RetCam wide-field infant fundus image: 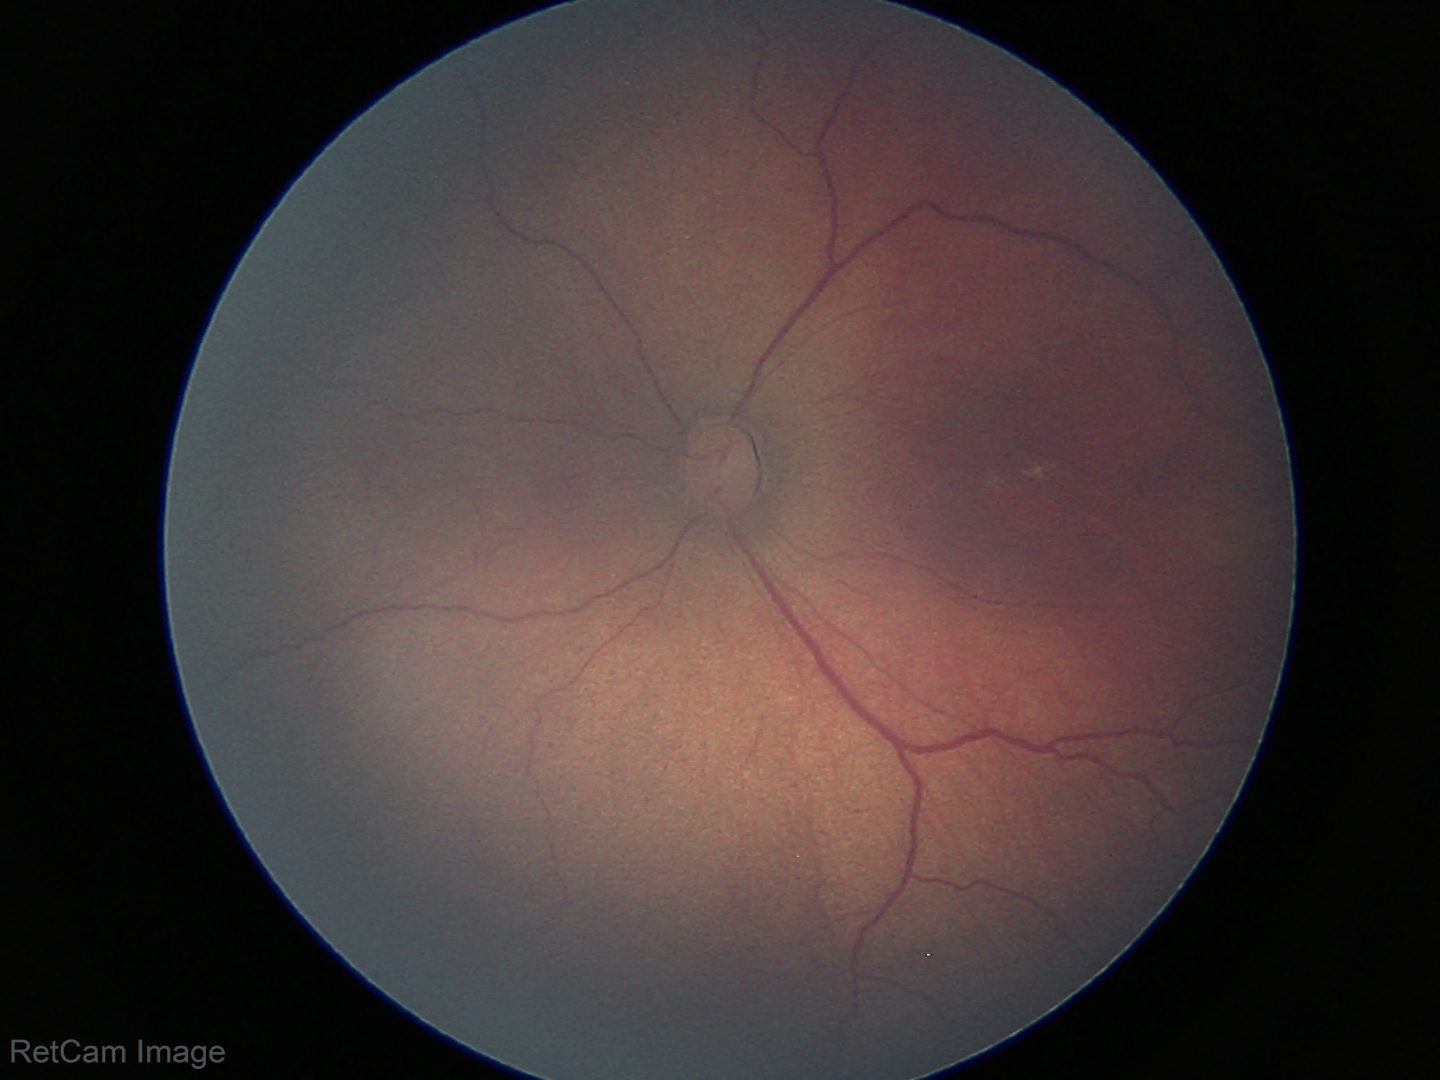 Screening diagnosis: retinopathy of prematurity stage 3, plus form: absent — posterior pole vessels without abnormal dilation or tortuosity.